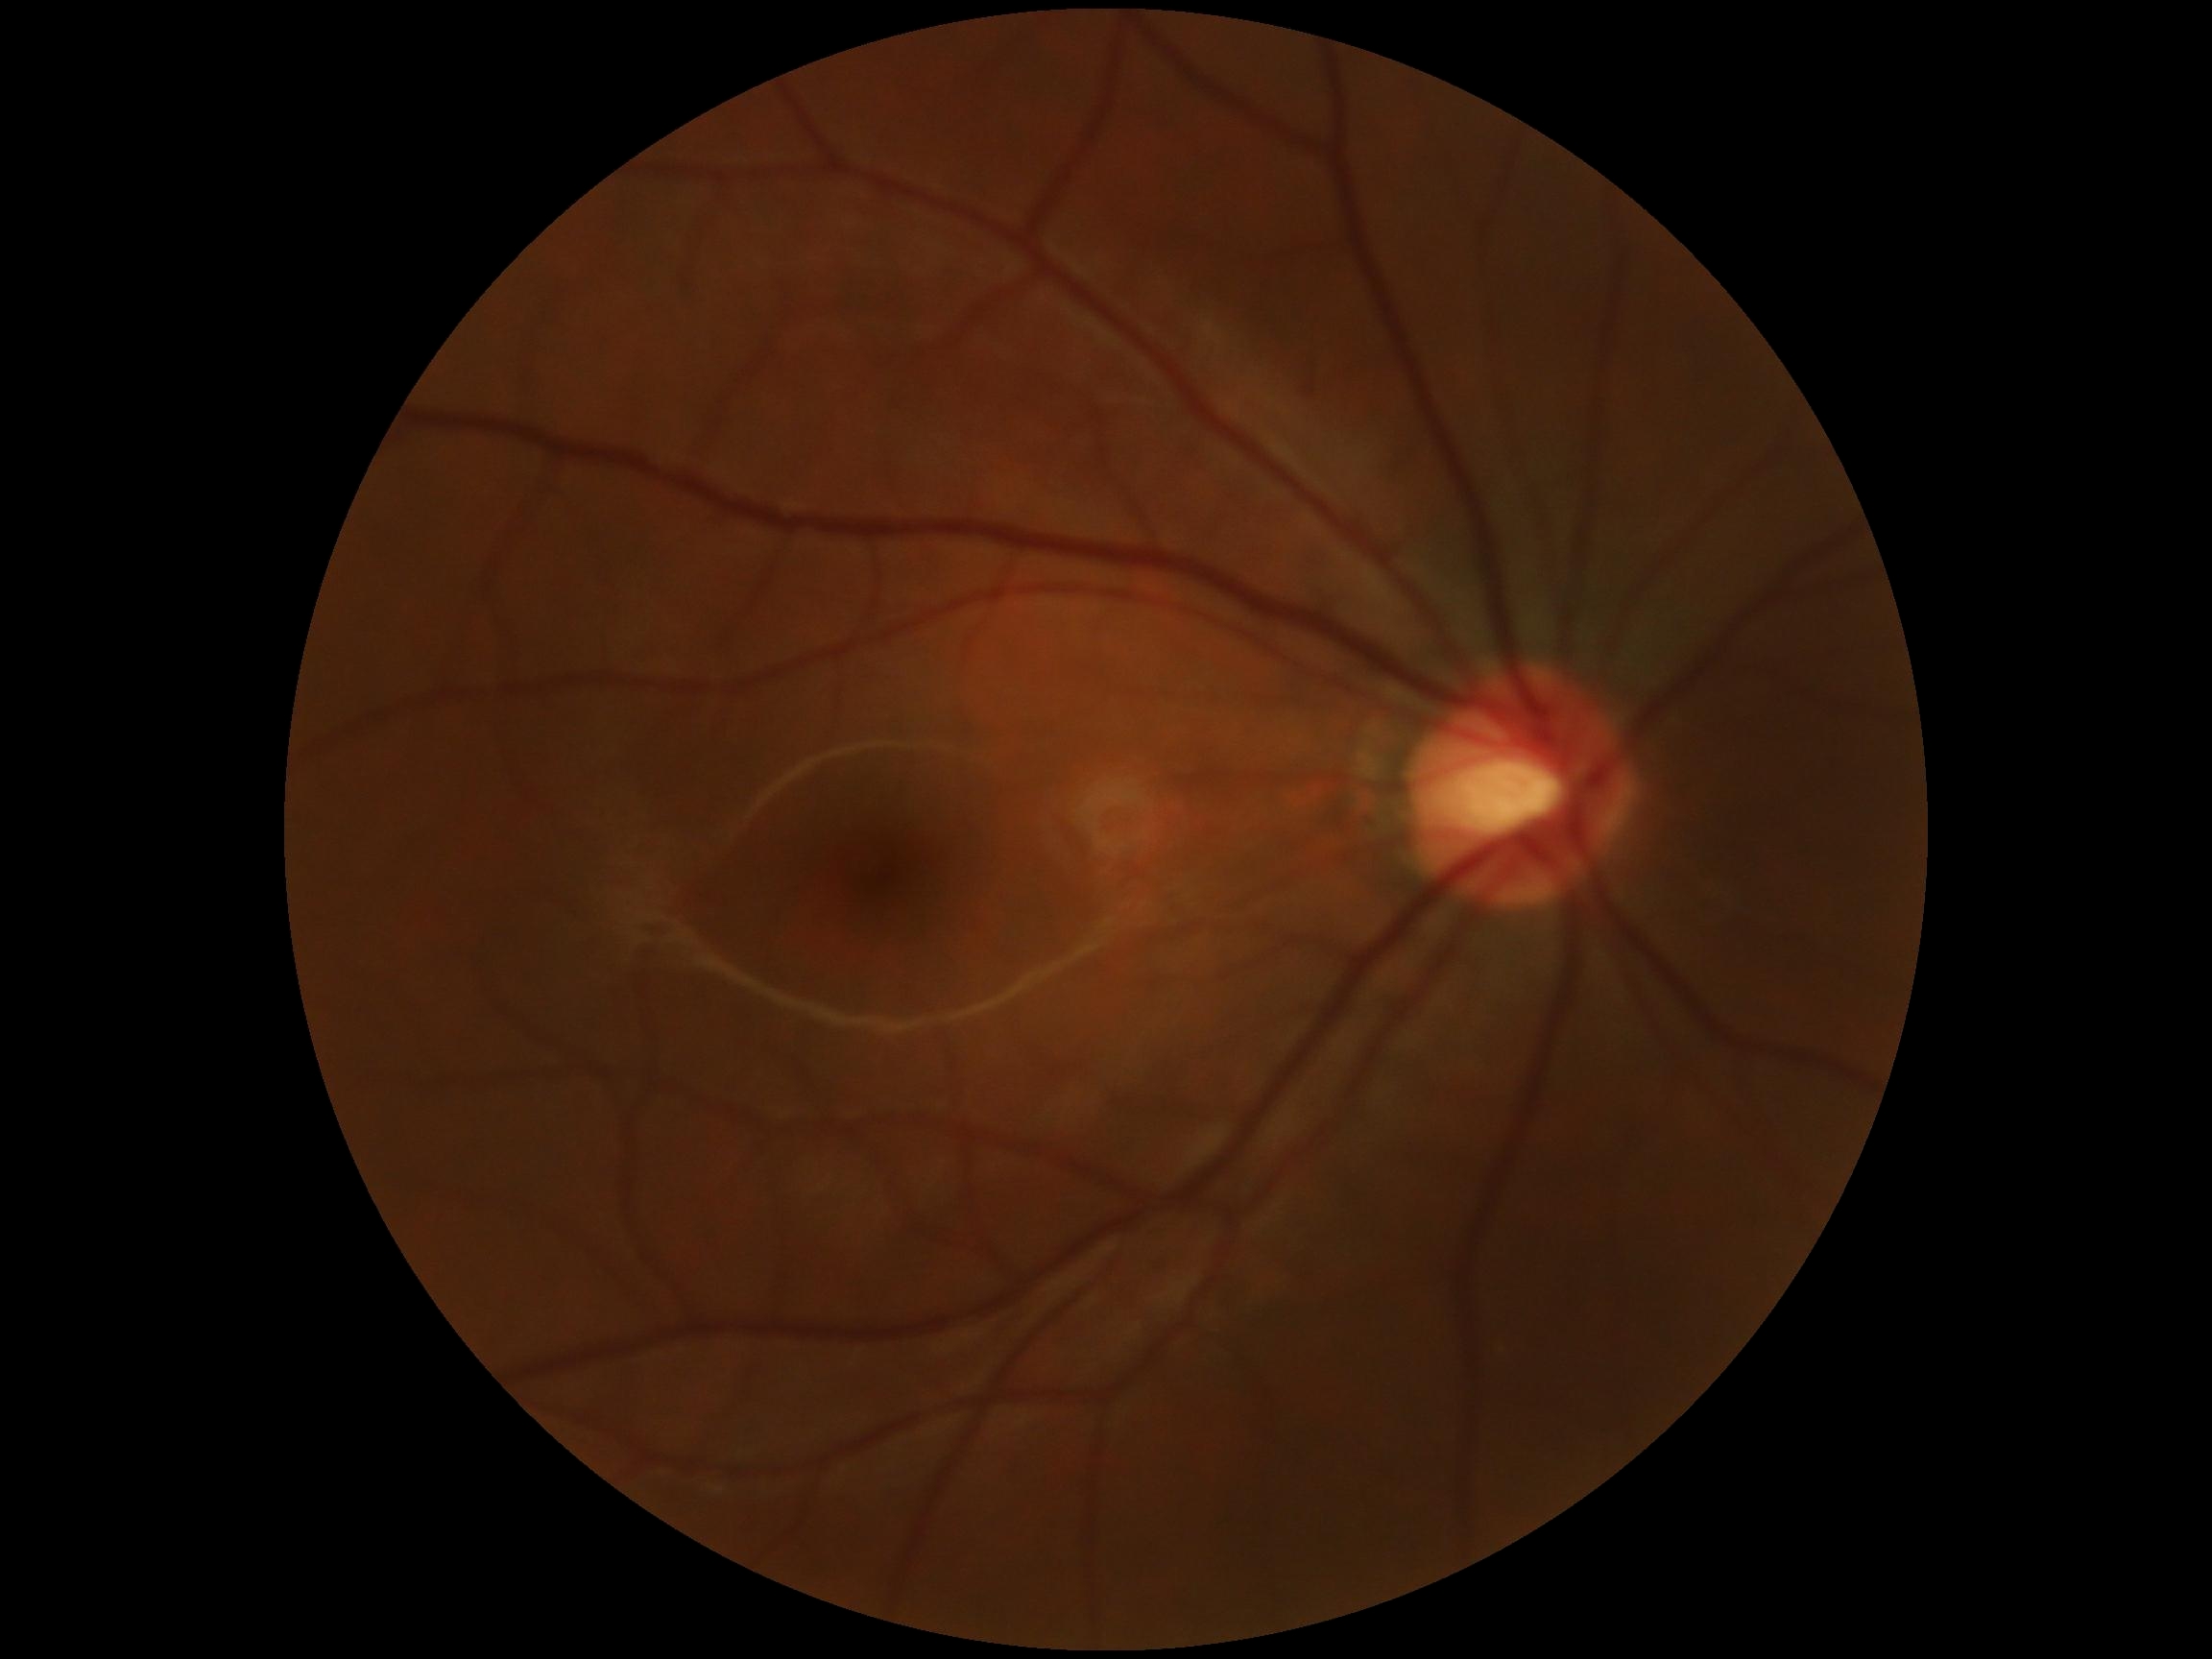
DR grade is no apparent diabetic retinopathy (0).